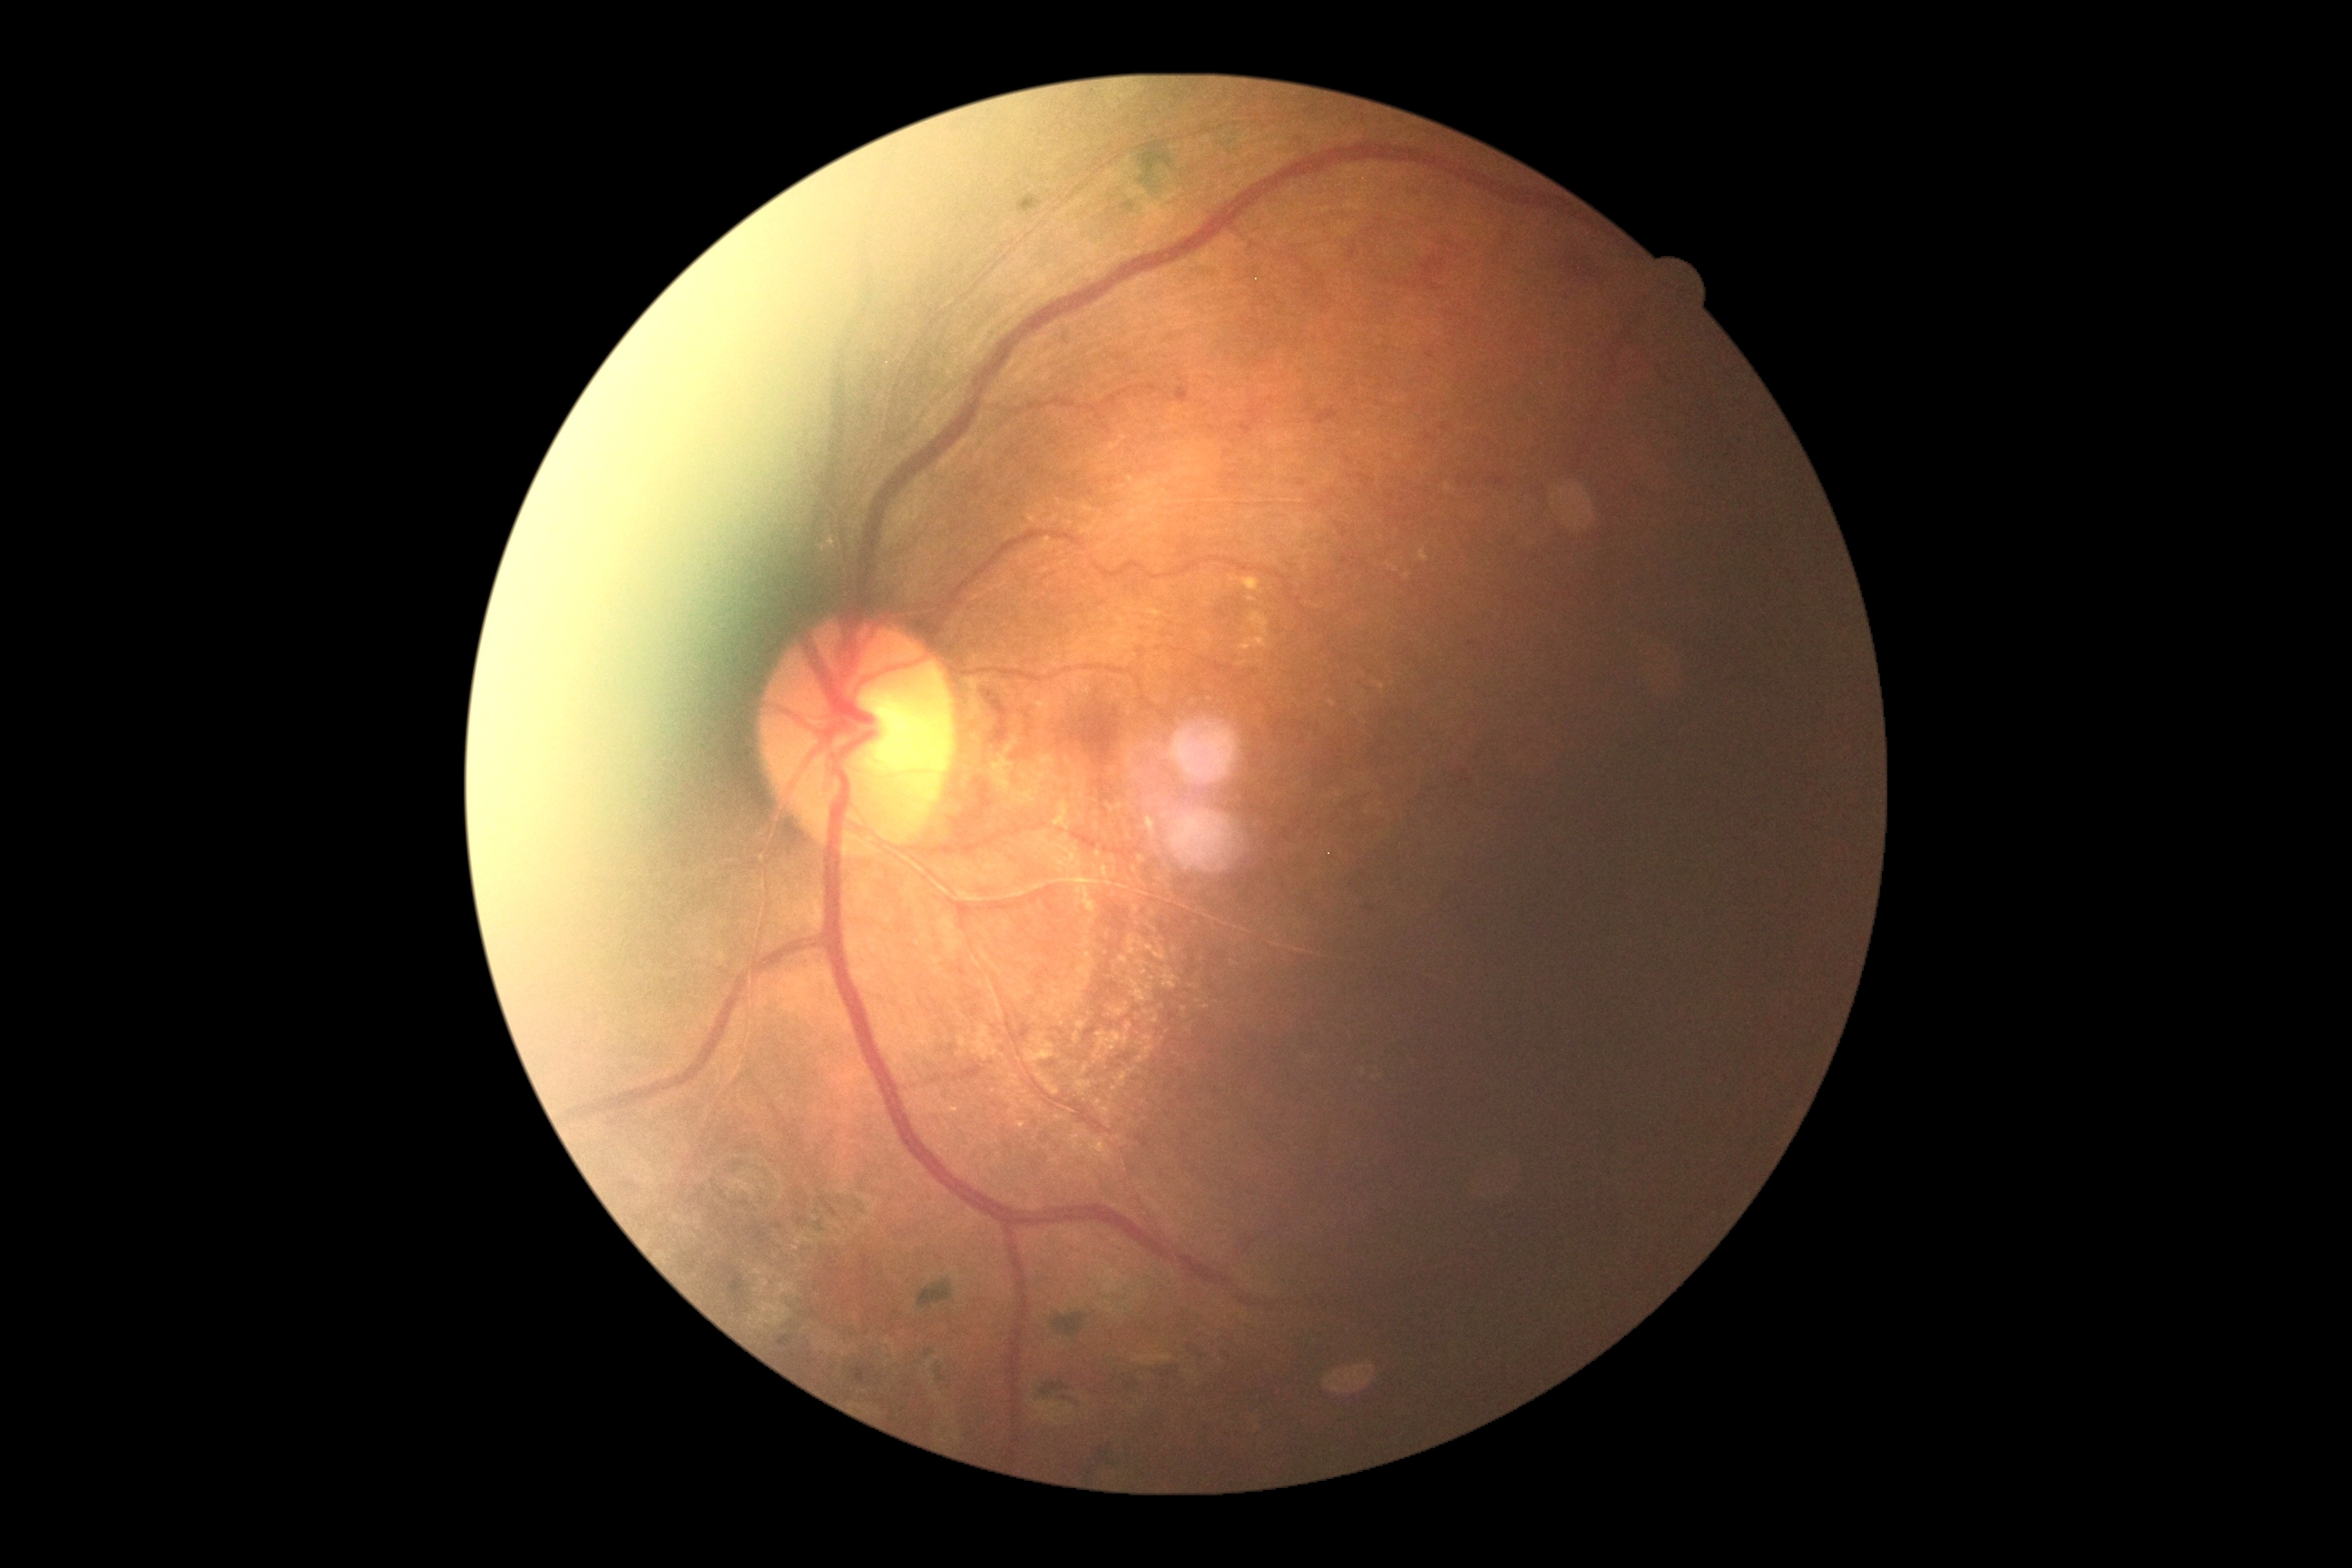

DR: 2/4